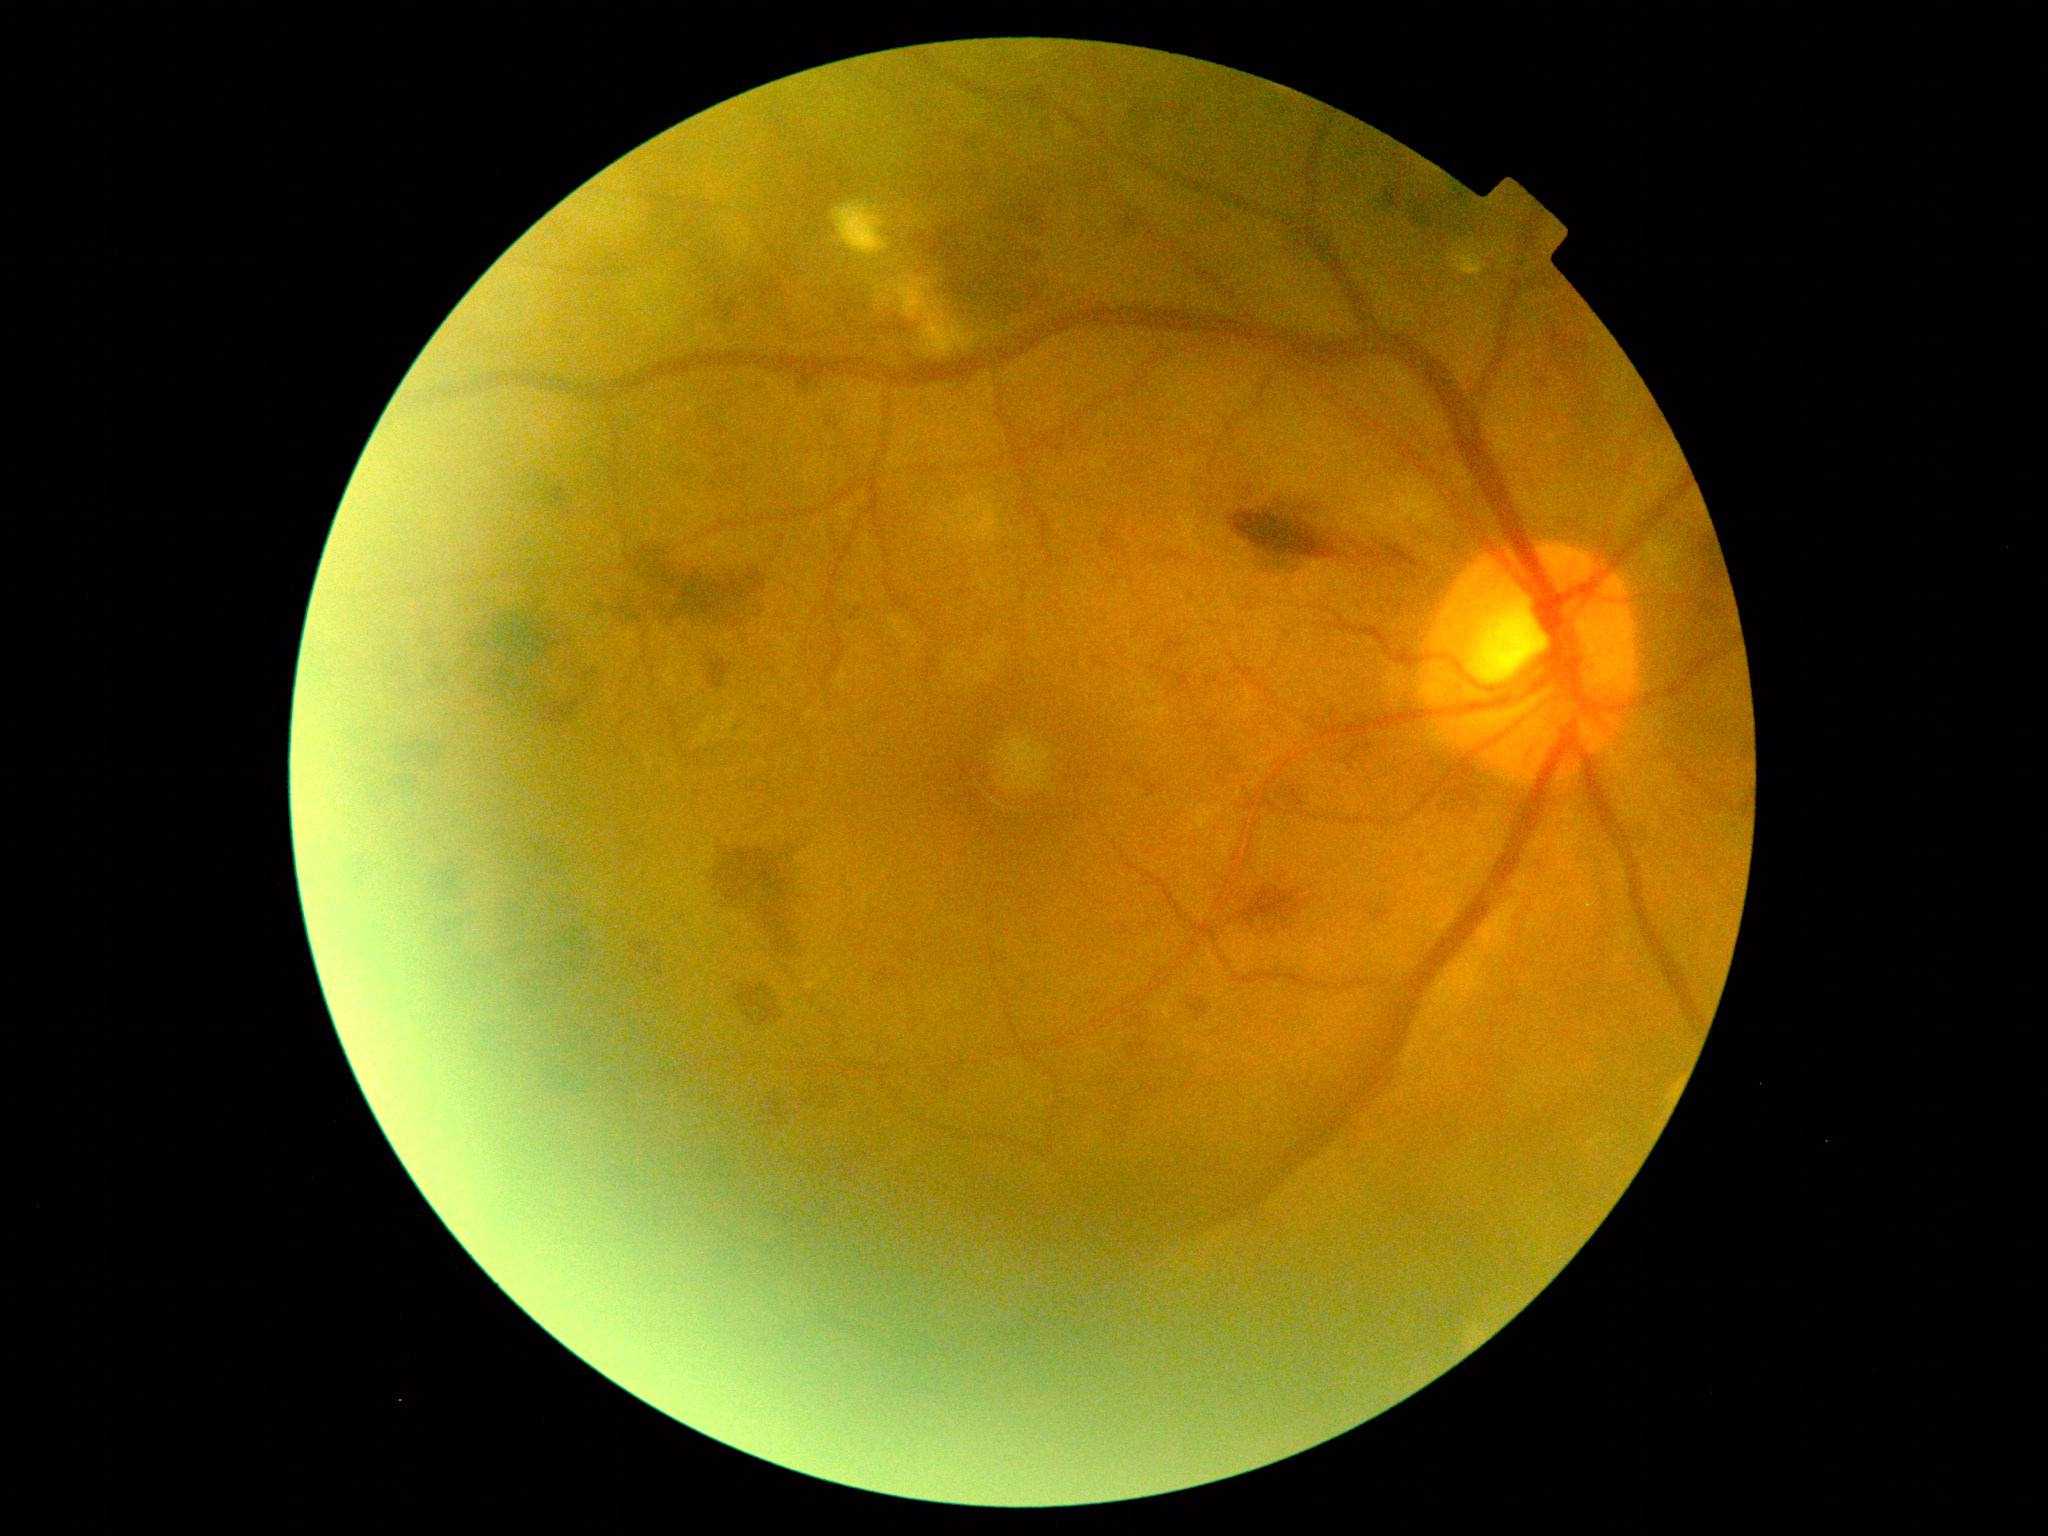
Diabetic retinopathy severity is grade 2.